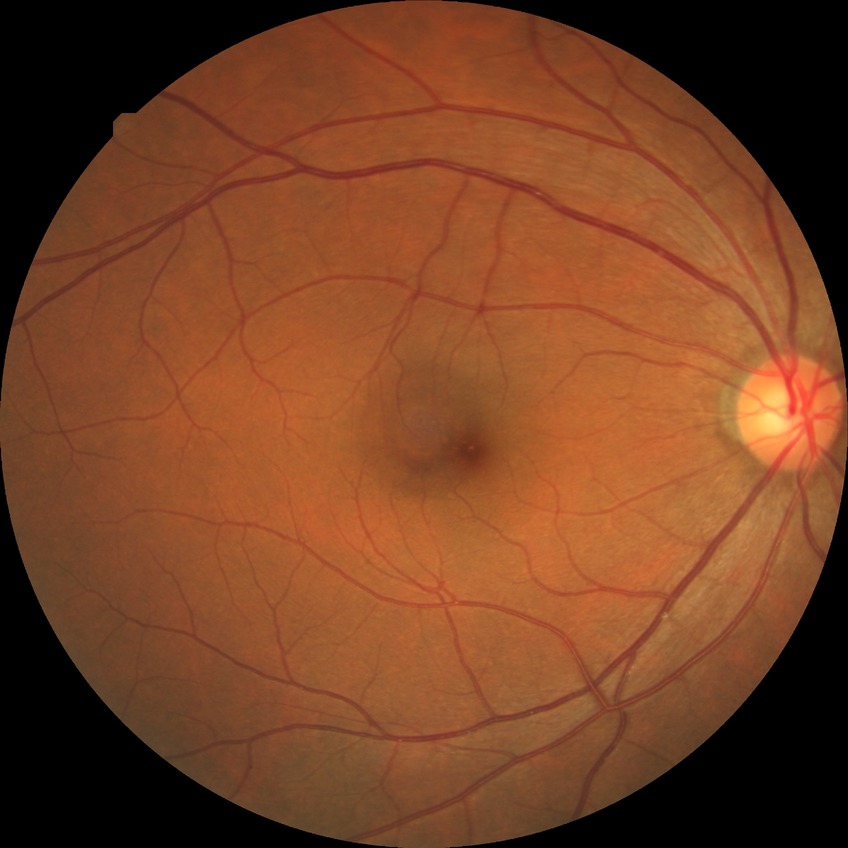

Diabetic retinopathy (DR): no diabetic retinopathy (NDR).